848x848, acquired with a NIDEK AFC-230 — 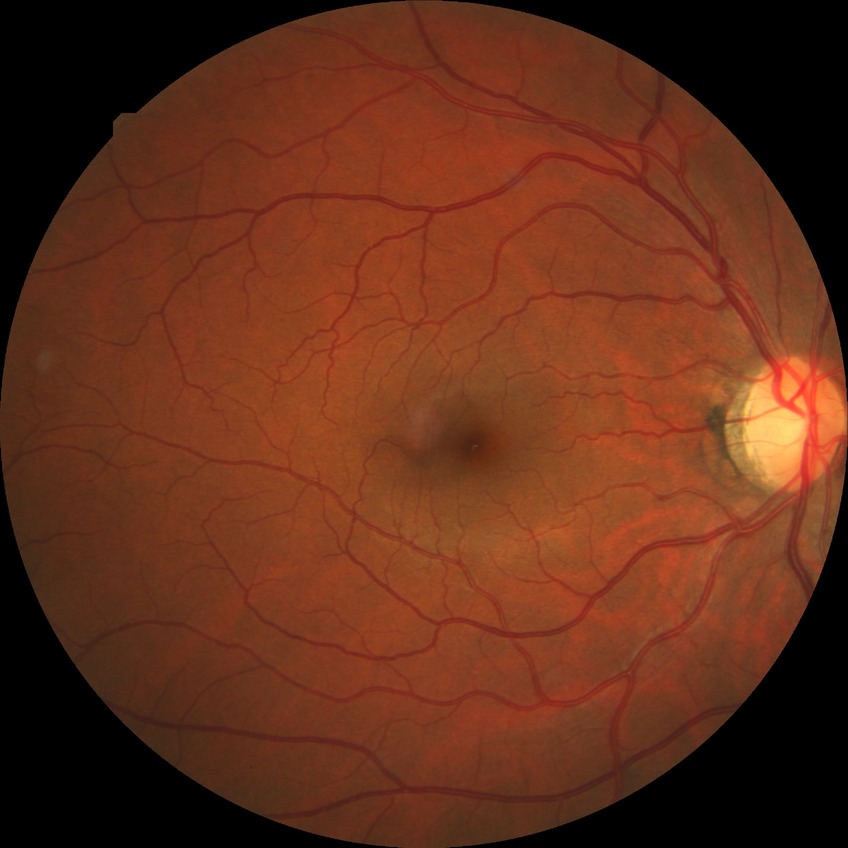
diabetic retinopathy stage=no diabetic retinopathy.